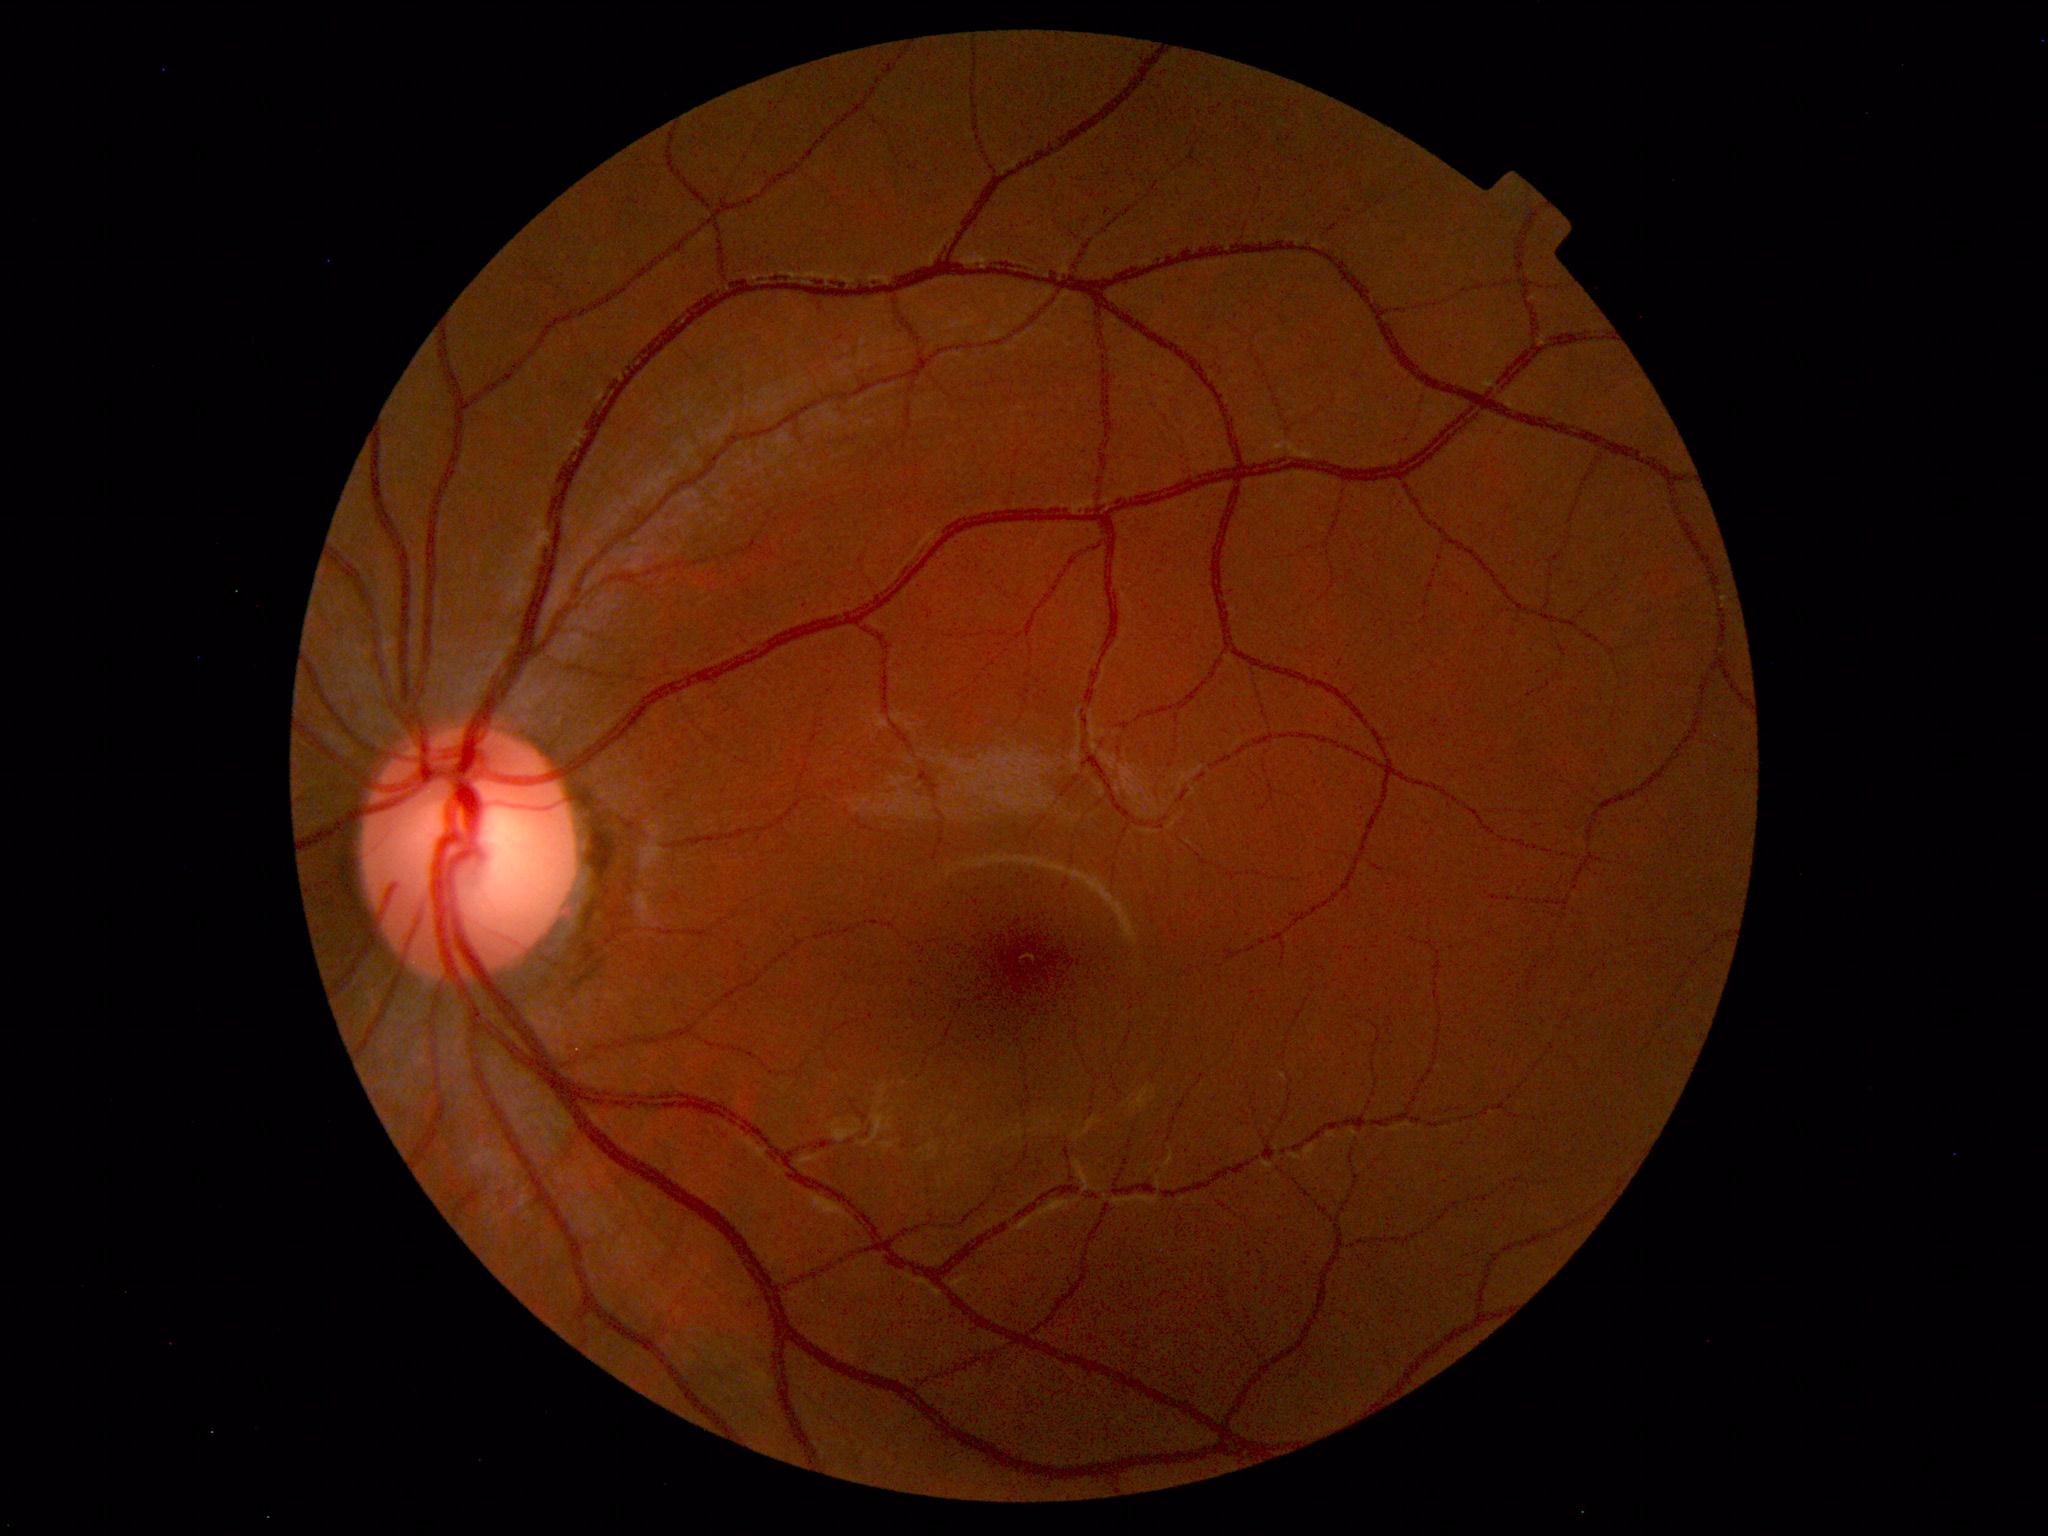

Normal color fundus photograph.